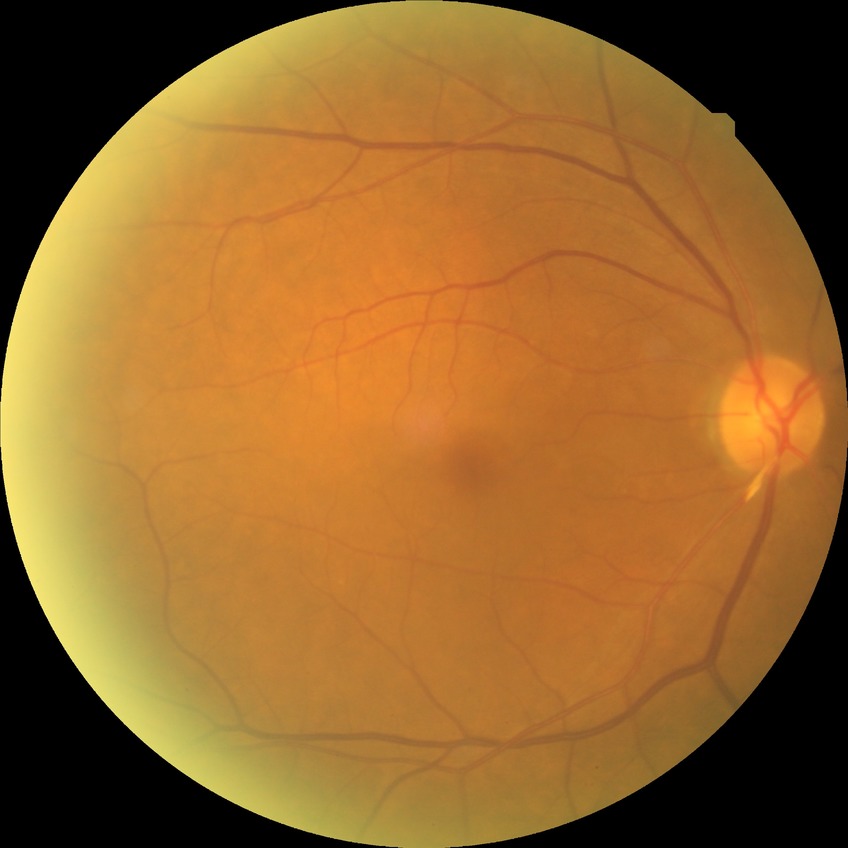

Diabetic retinopathy (DR) is NDR (no diabetic retinopathy).